848x848px. Without pupil dilation. Fundus photo. NIDEK AFC-230 fundus camera: 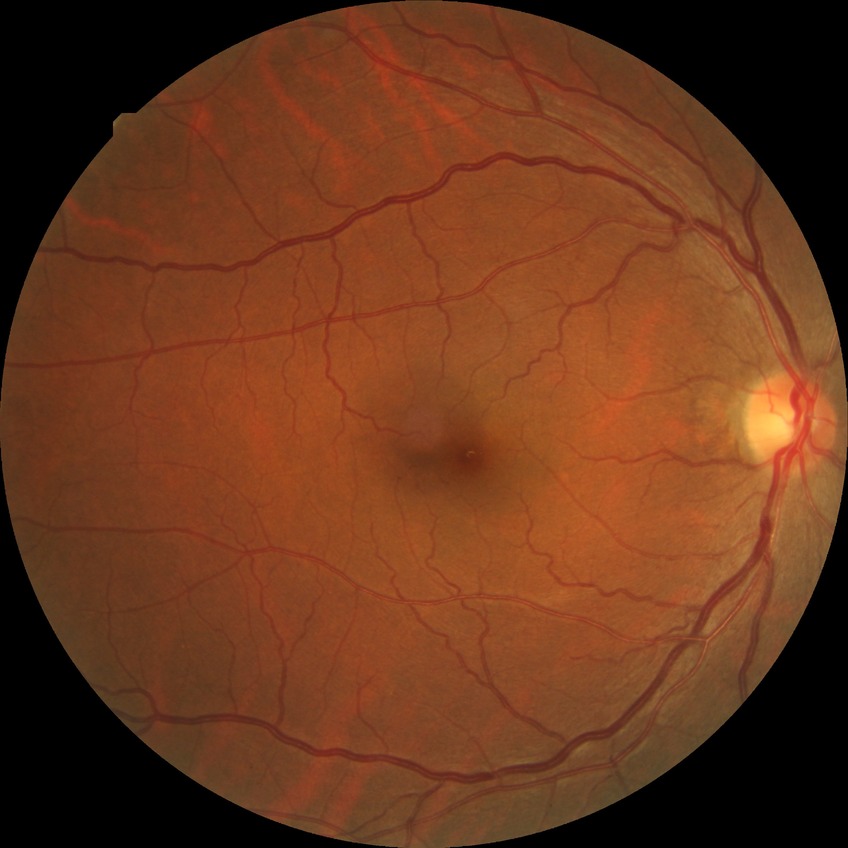 Davis grade is NDR.